Infant wide-field retinal image · acquired on the Clarity RetCam 3 · 640 x 480 pixels
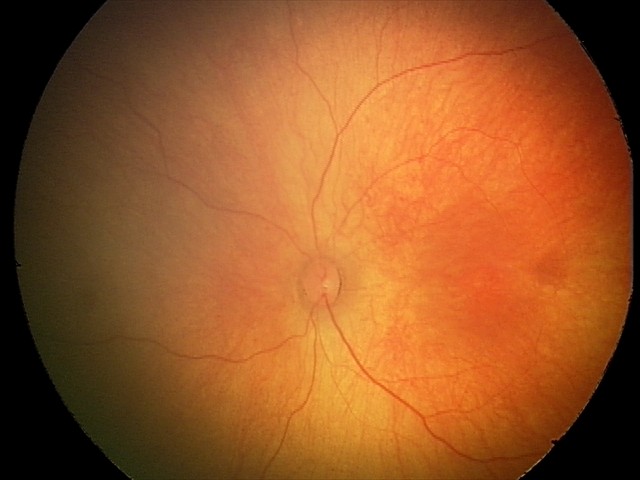 Finding = physiological appearance.